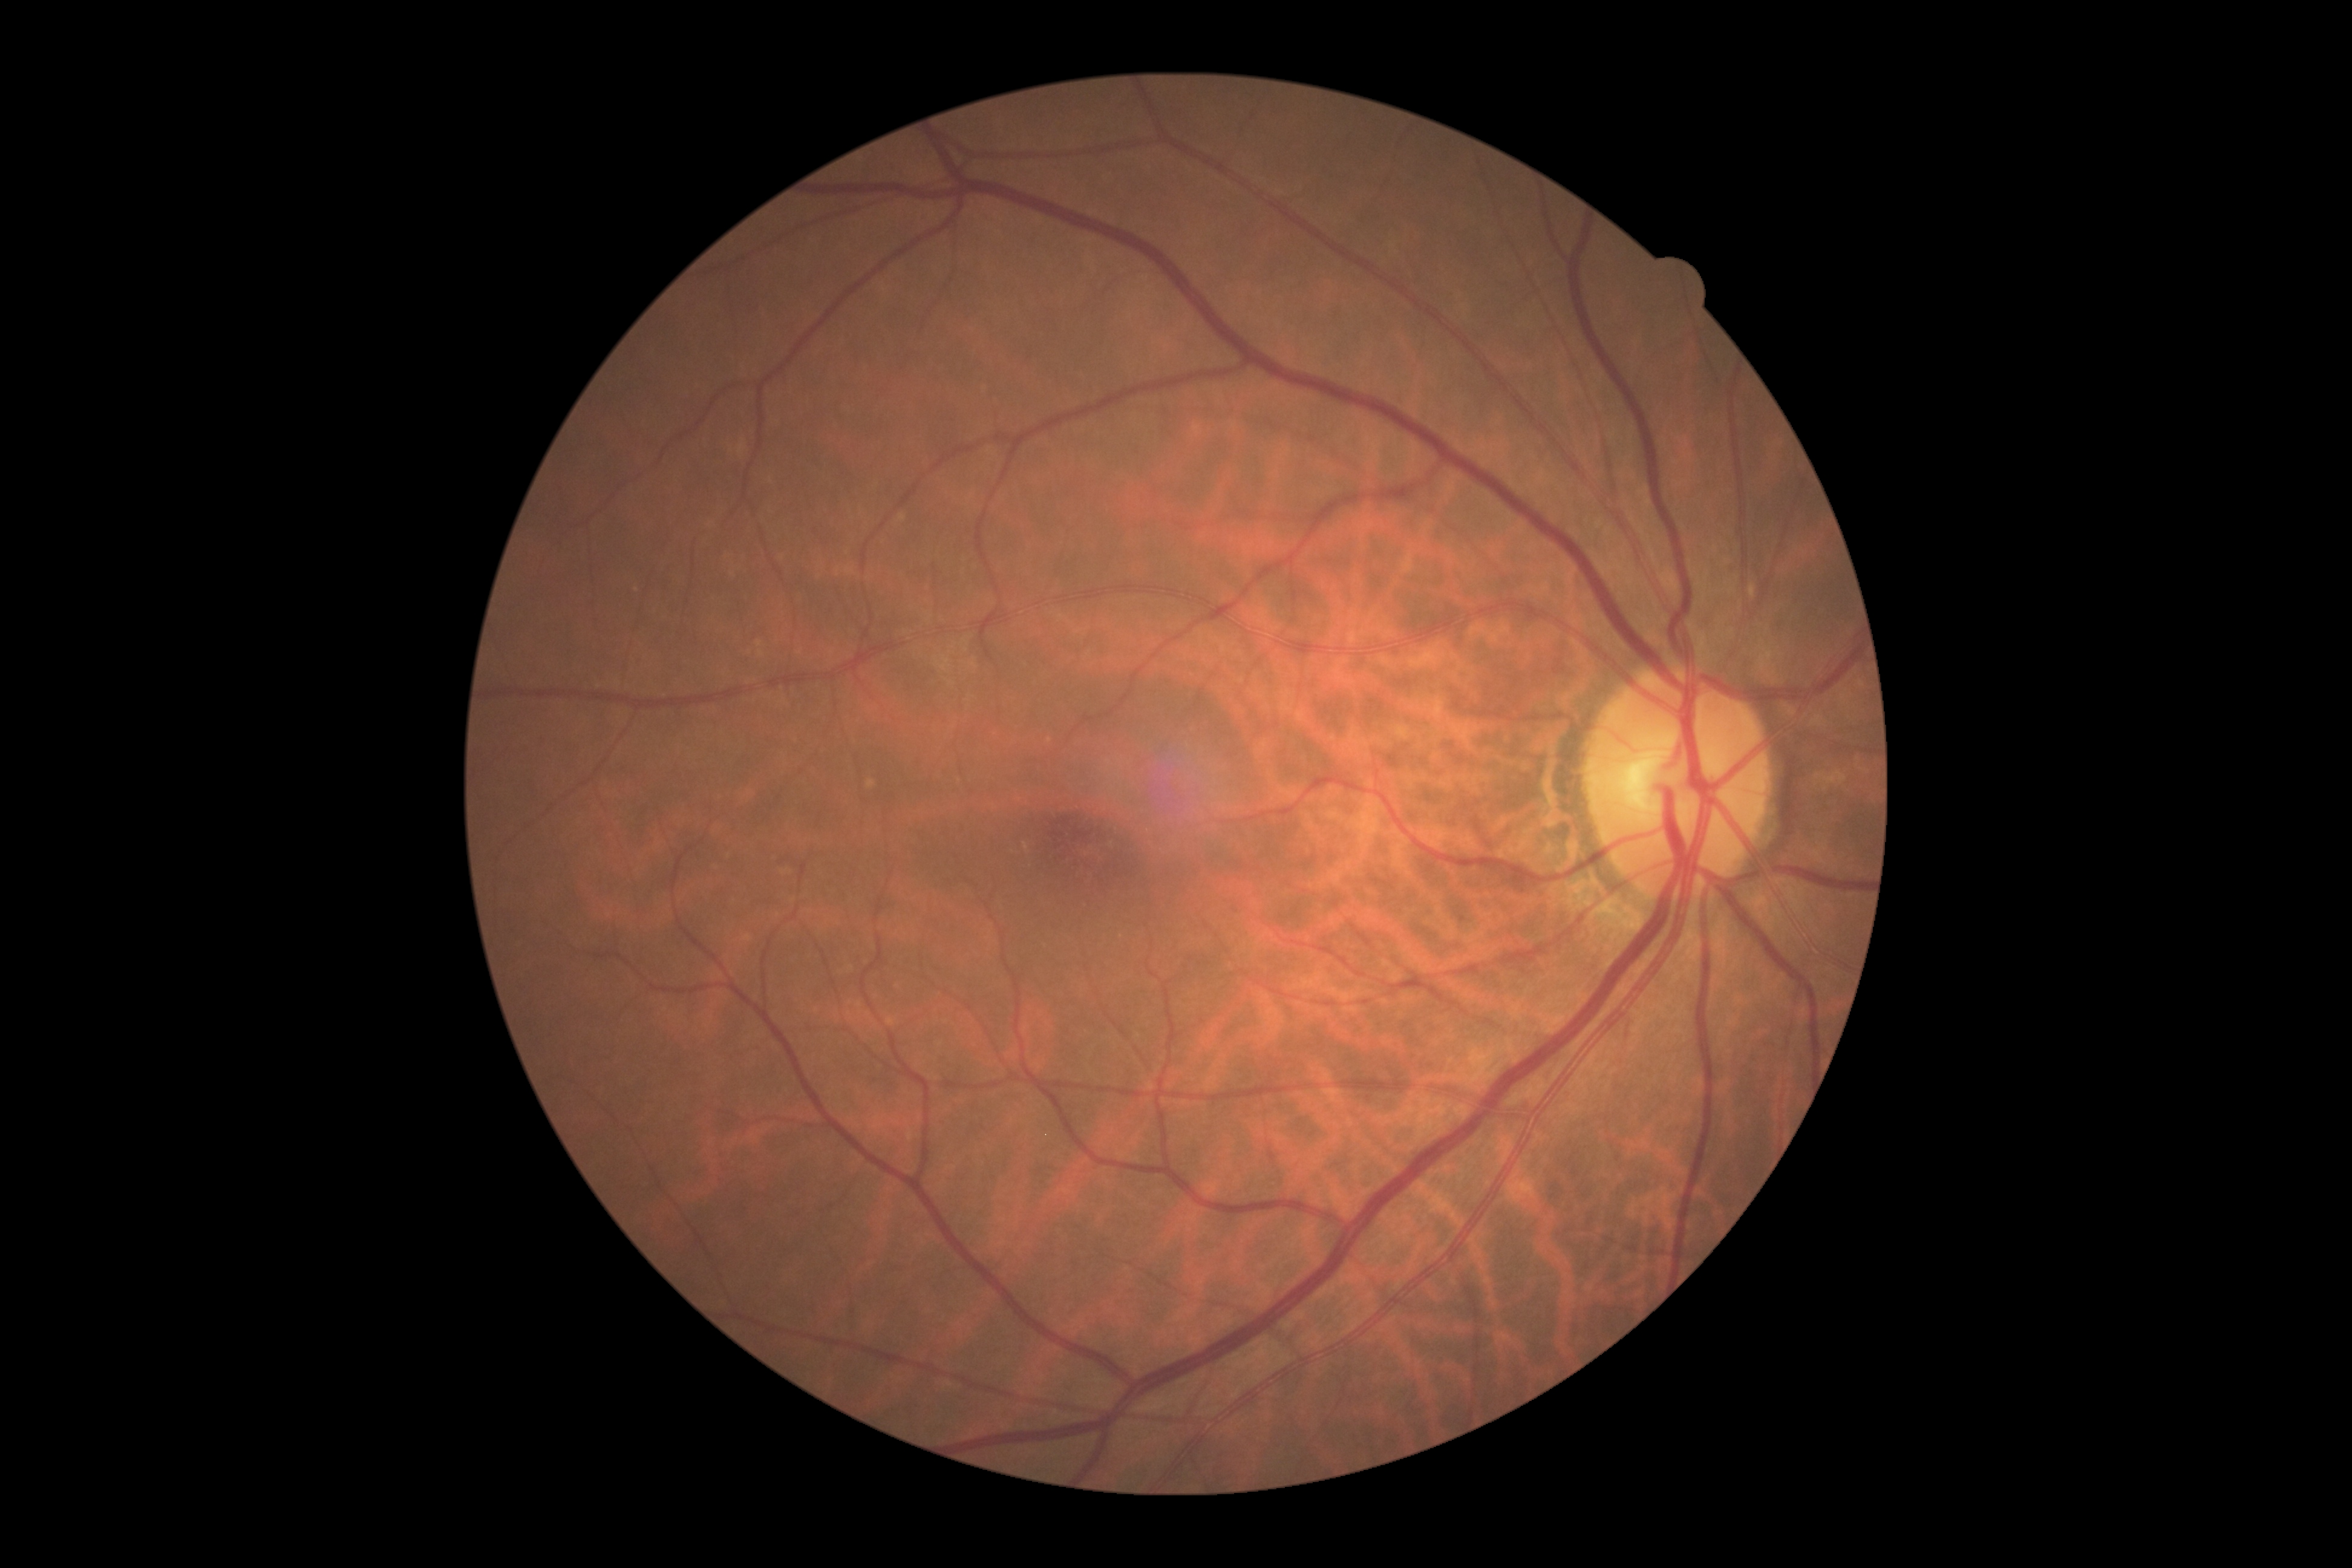
- DR: no apparent retinopathy (grade 0) — no visible signs of diabetic retinopathy